Pediatric retinal photograph (wide-field).
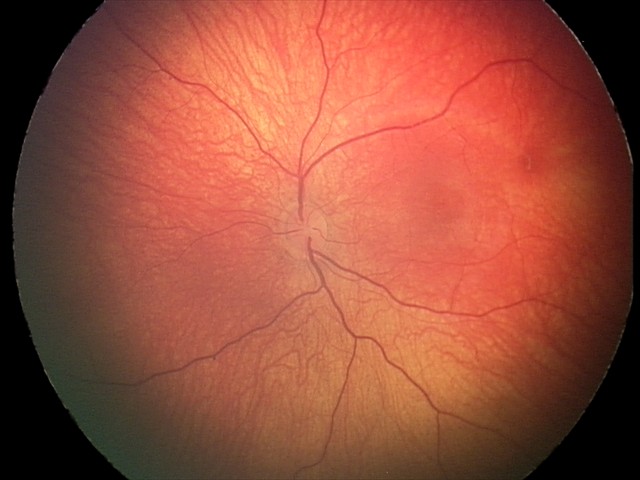 Series diagnosed as retinal hemorrhages.